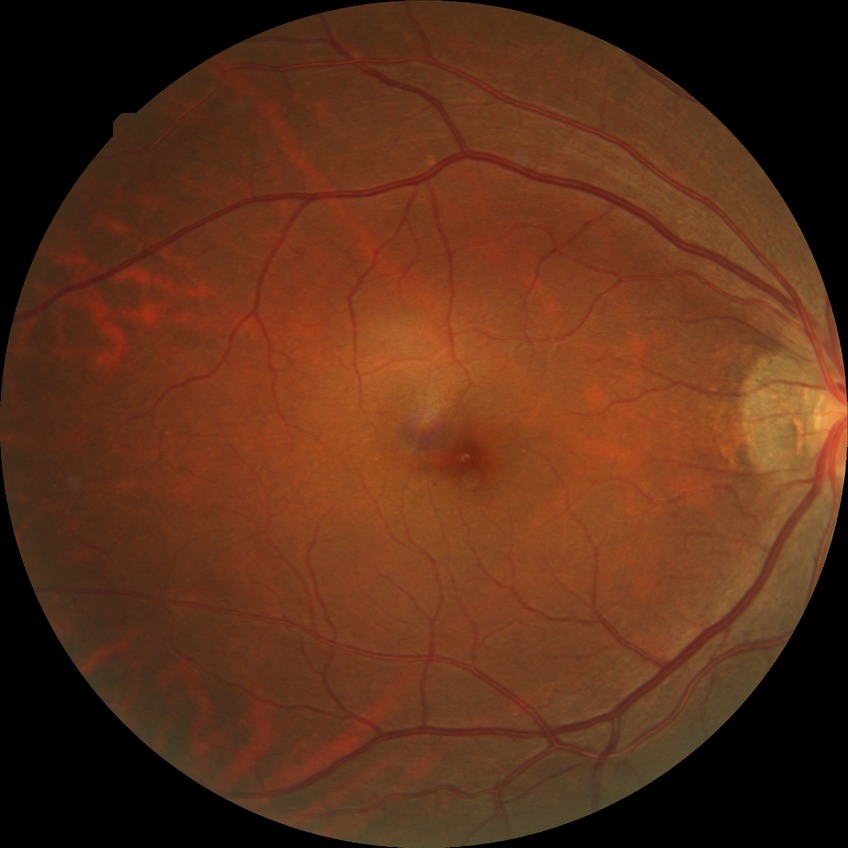
Diabetic retinopathy (DR): NDR (no diabetic retinopathy).